UWF retinal mosaic: 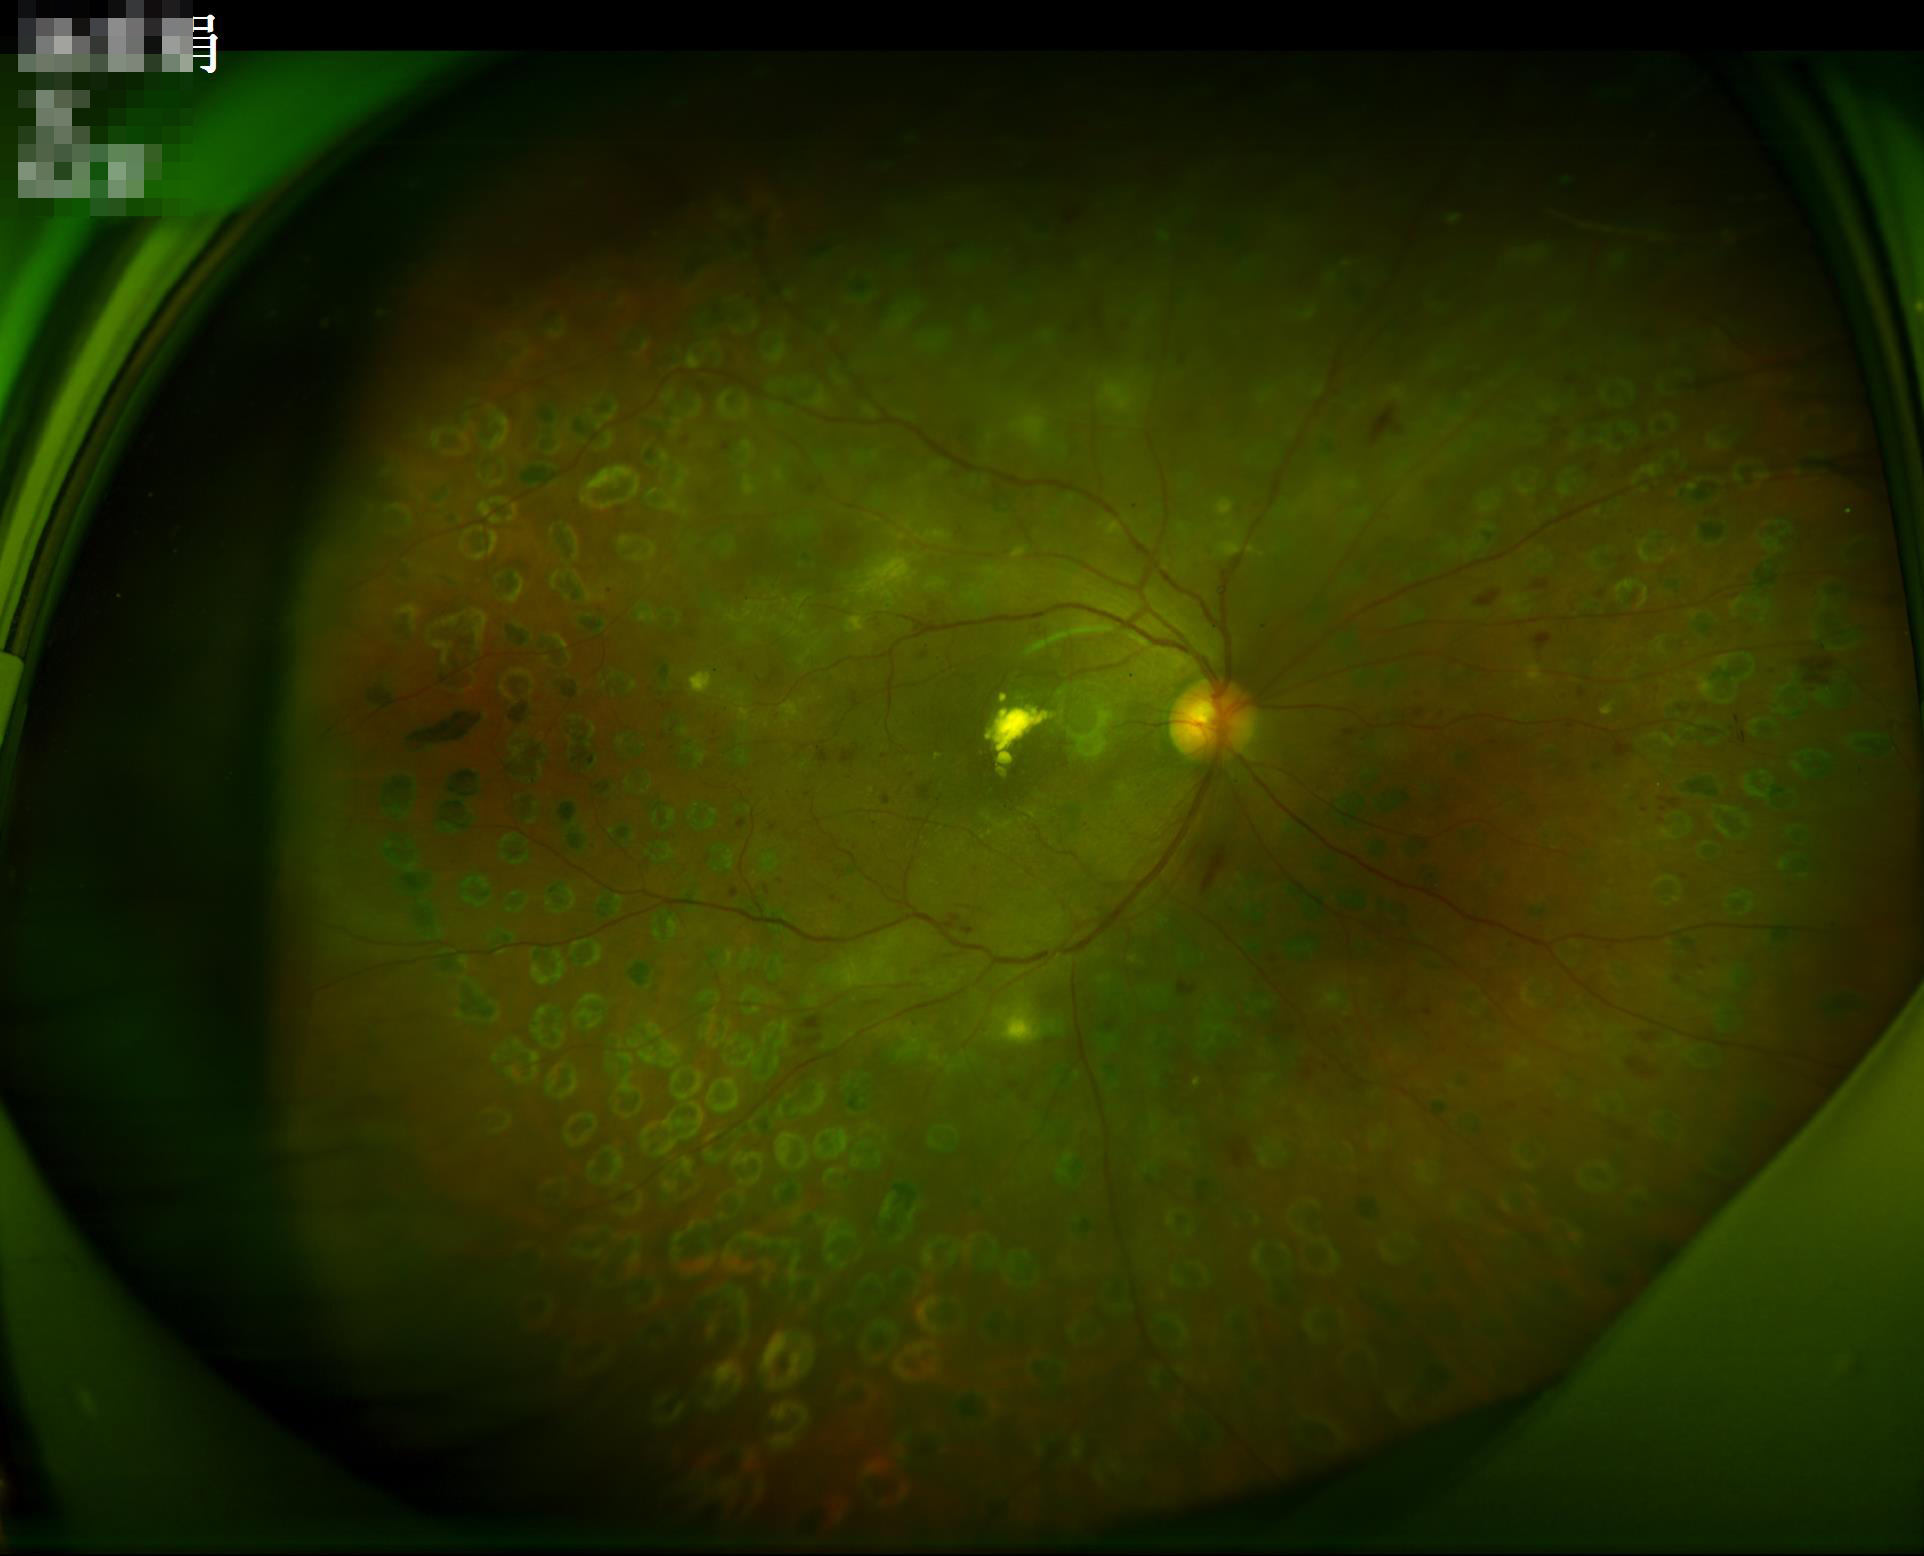 Quality grading: overall: good, gradable | illumination: even and well-balanced | sharpness: sharp throughout the field.